RetCam wide-field infant fundus image. 1440x1080. Natus RetCam Envision, 130° FOV: 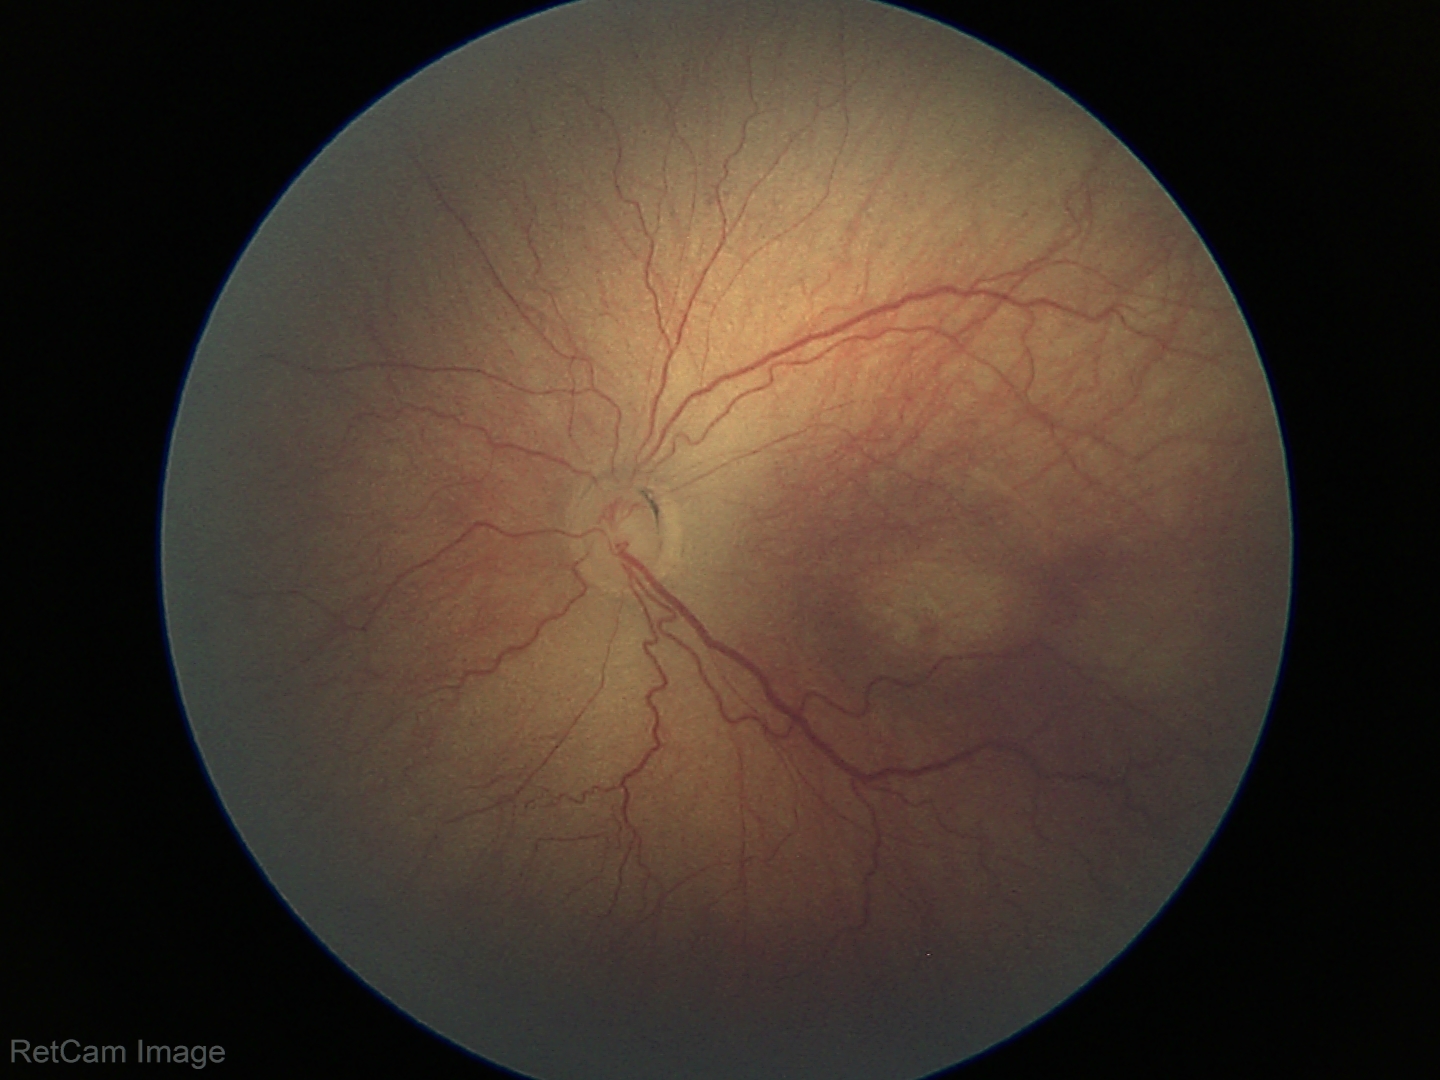
Plus disease absent. Screening series with retinopathy of prematurity stage 3 — ridge with extraretinal fibrovascular proliferation.